Graded on the modified Davis scale:
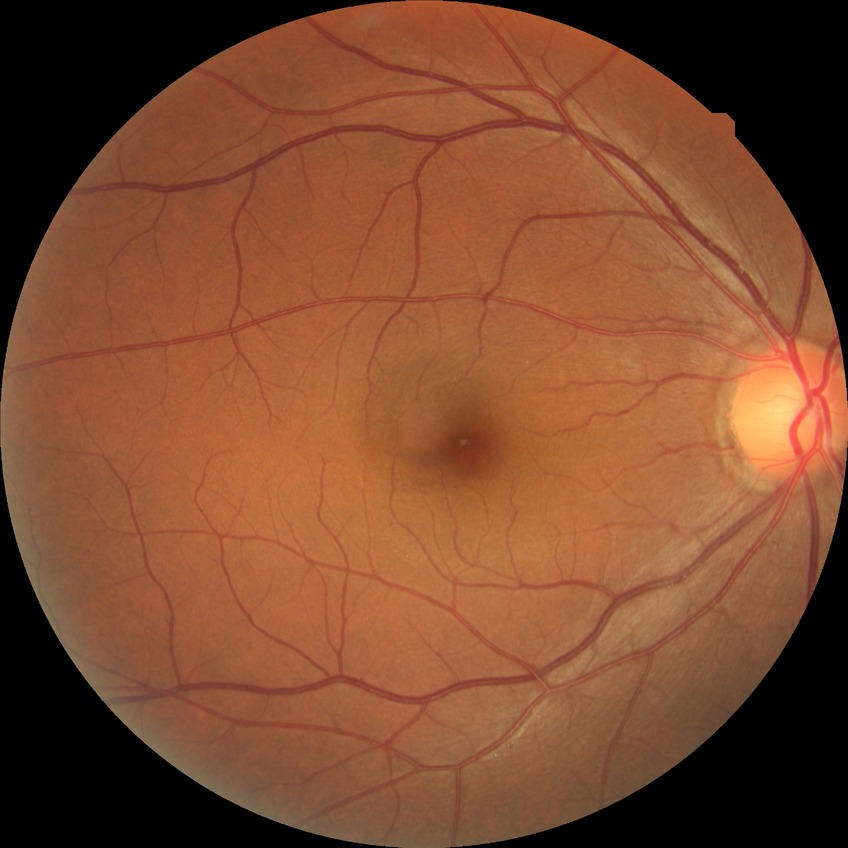

Diabetic retinopathy (DR): no diabetic retinopathy (NDR).